Nonmydriatic. 848x848. Diabetic retinopathy graded by the modified Davis classification.
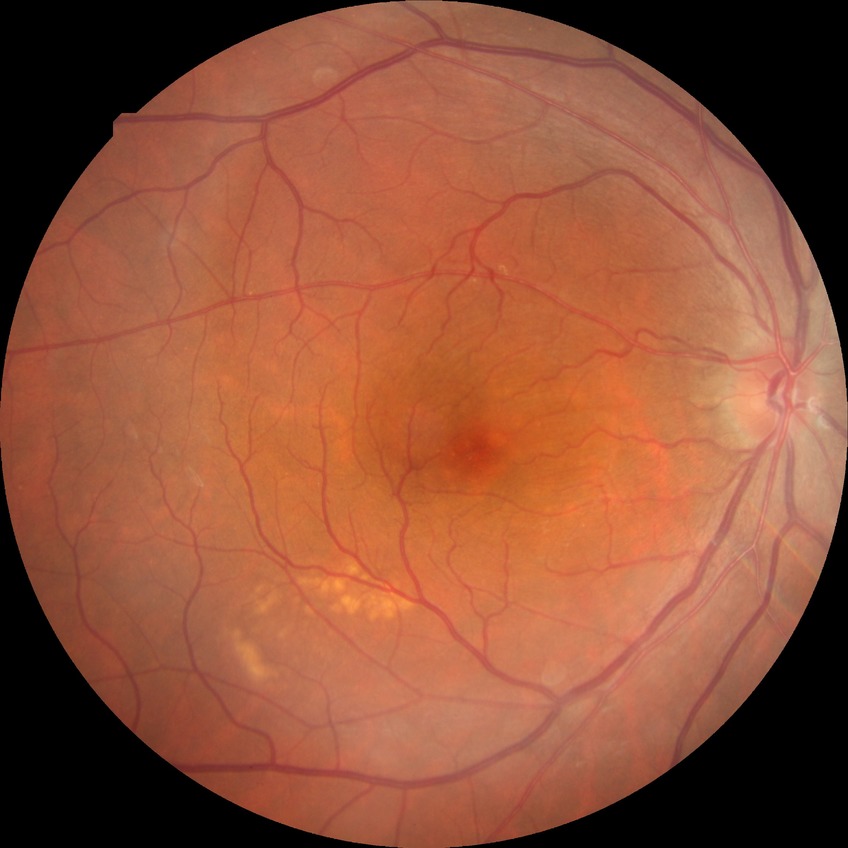
Diabetic retinopathy (DR): simple diabetic retinopathy (SDR).